UWF retinal mosaic — 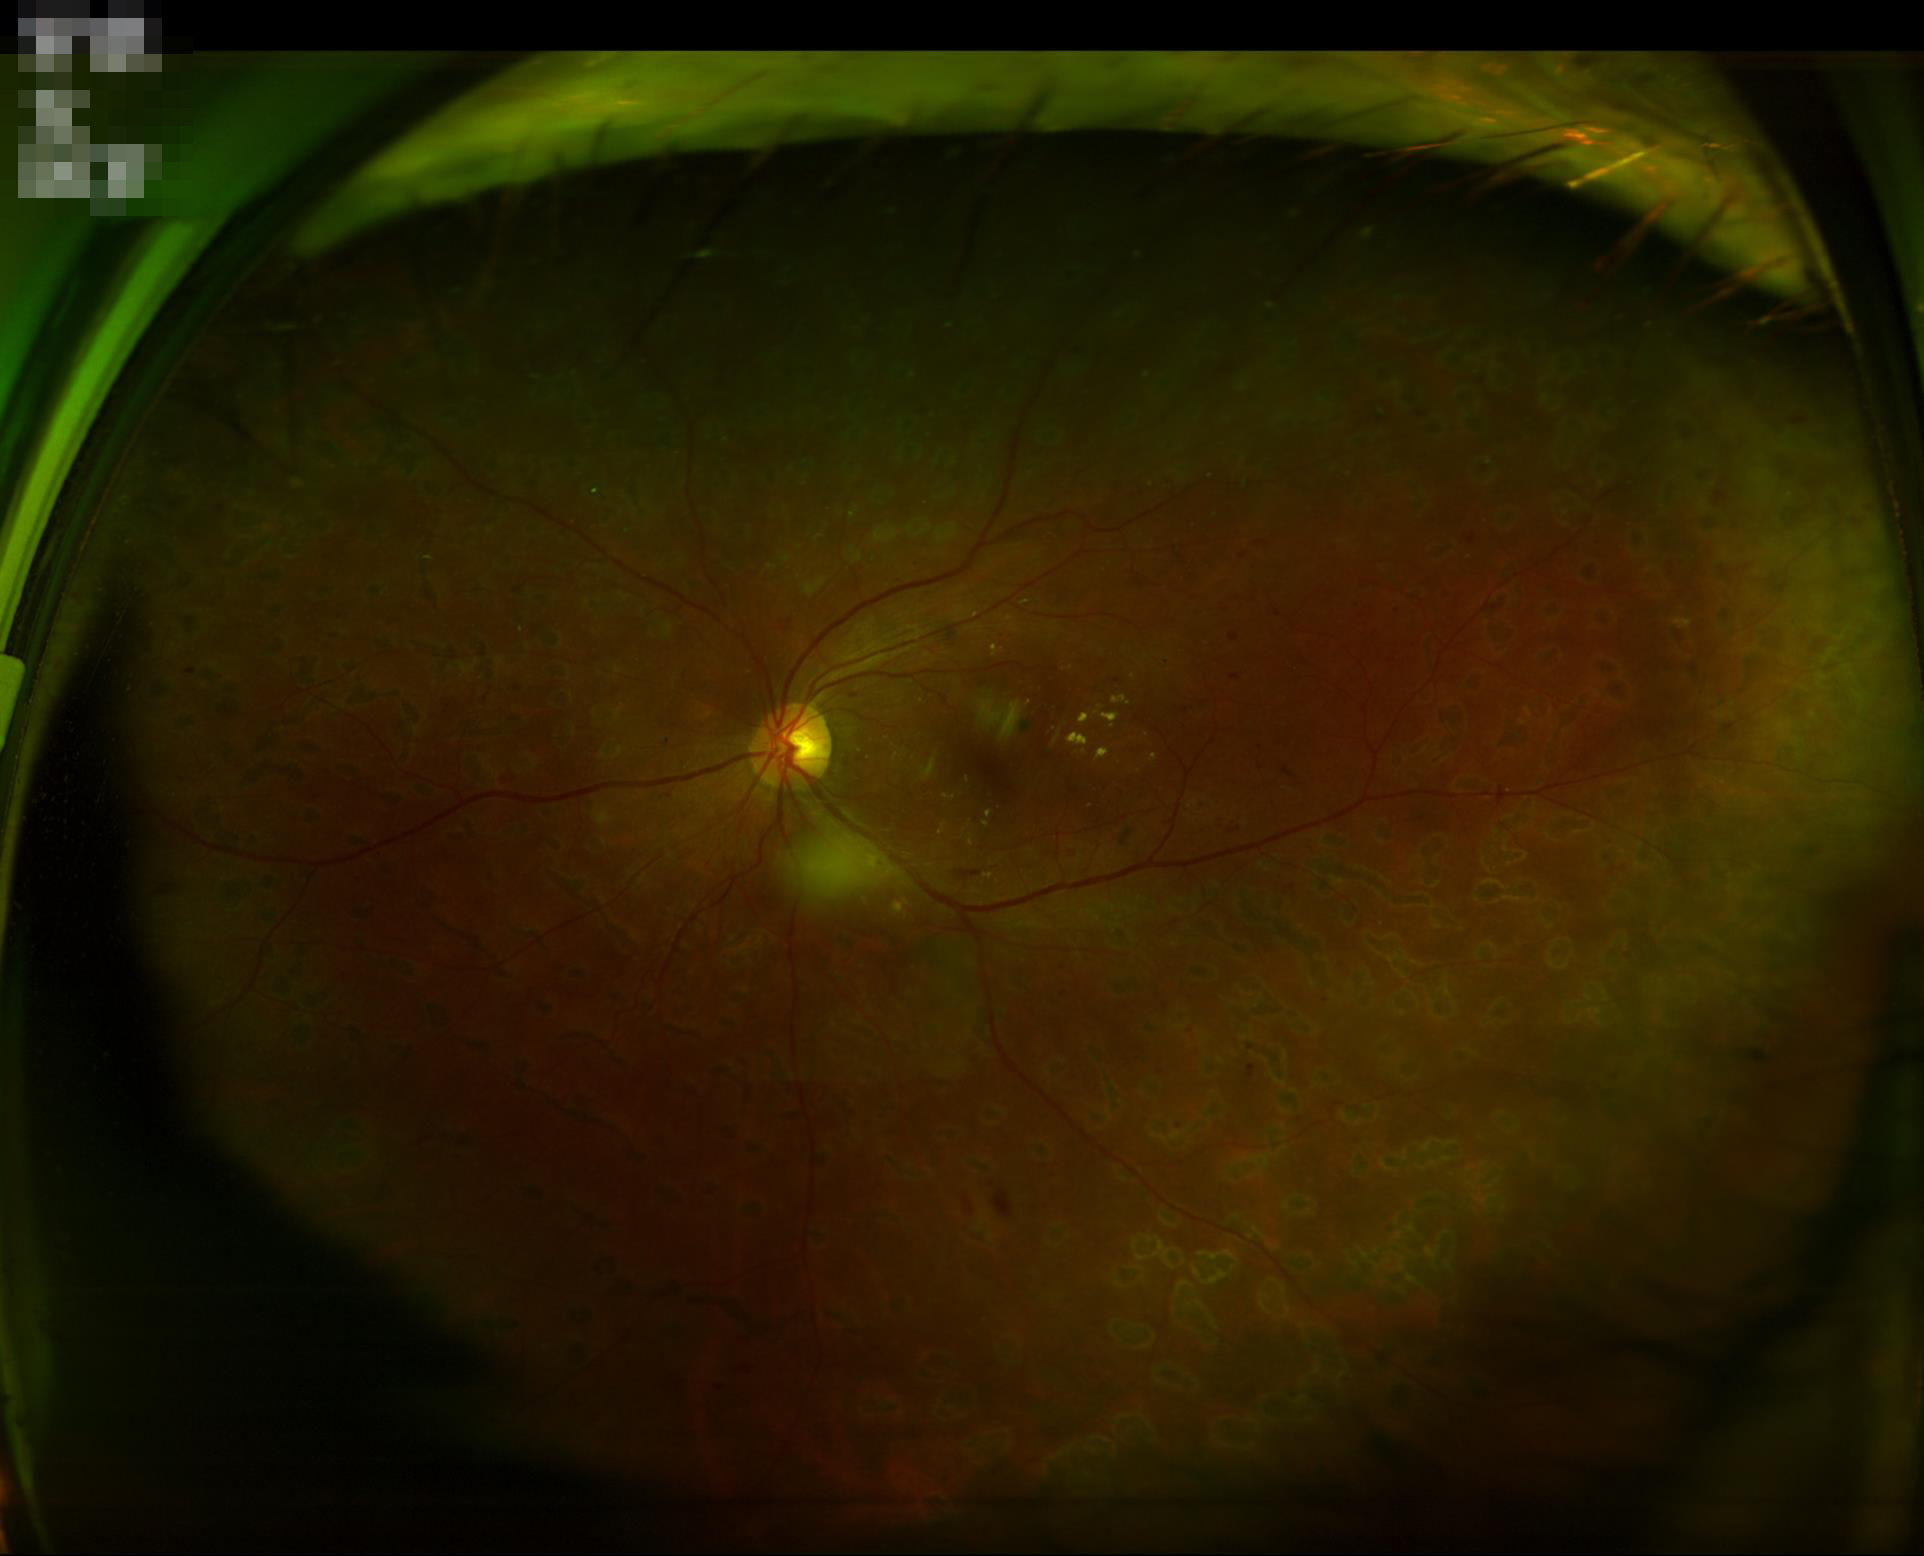 Vessels and details are readily distinguishable. No over- or under-exposure. Image quality is adequate for diagnostic use. Optic disc, vessels, and background are in focus.